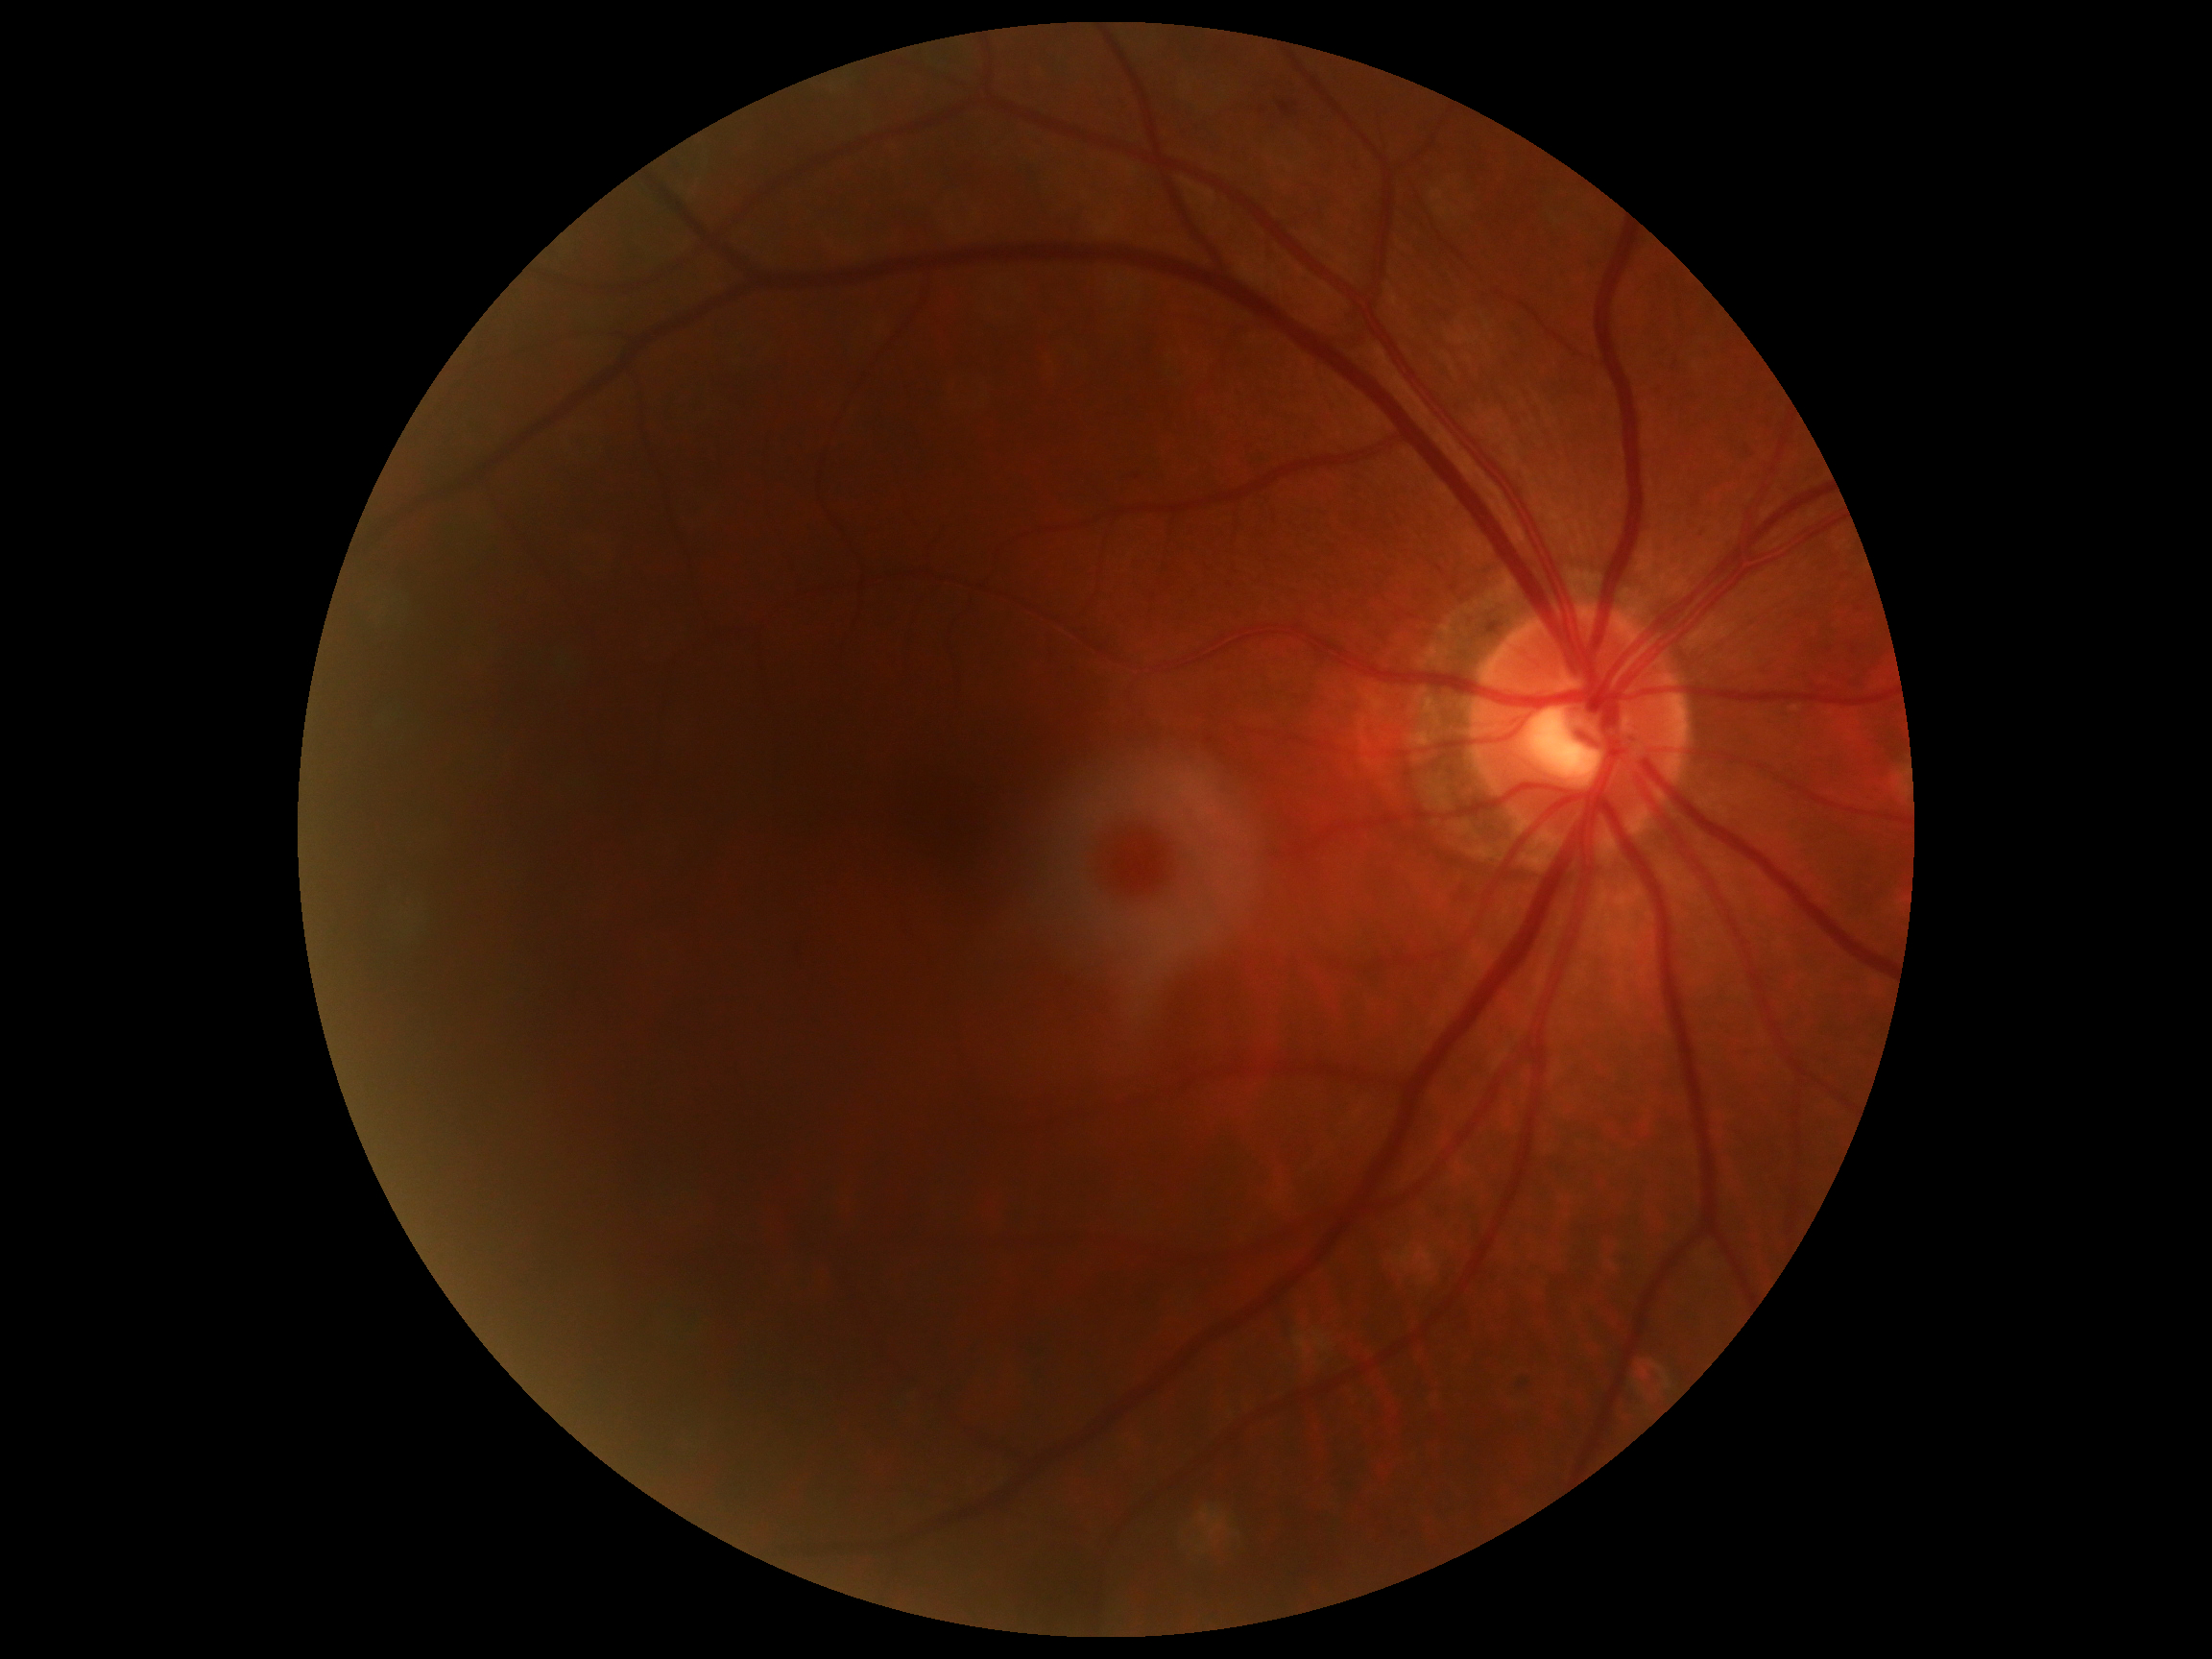
DR severity: grade 2.